848 by 848 pixels — 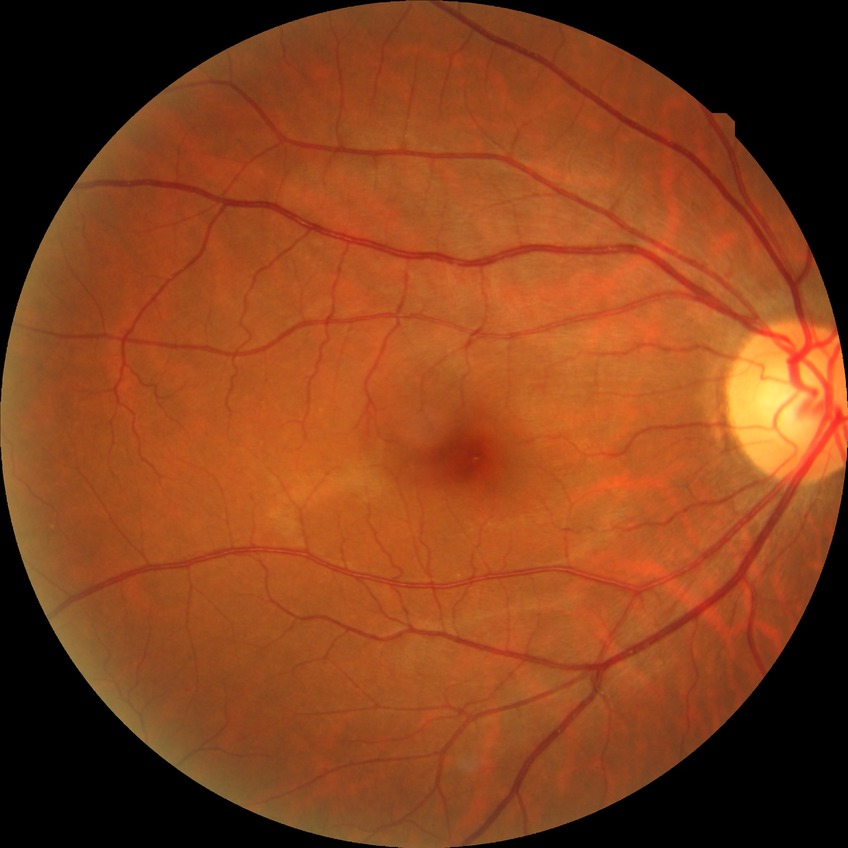

retinopathy grade = no diabetic retinopathy.